Portable fundus camera image: 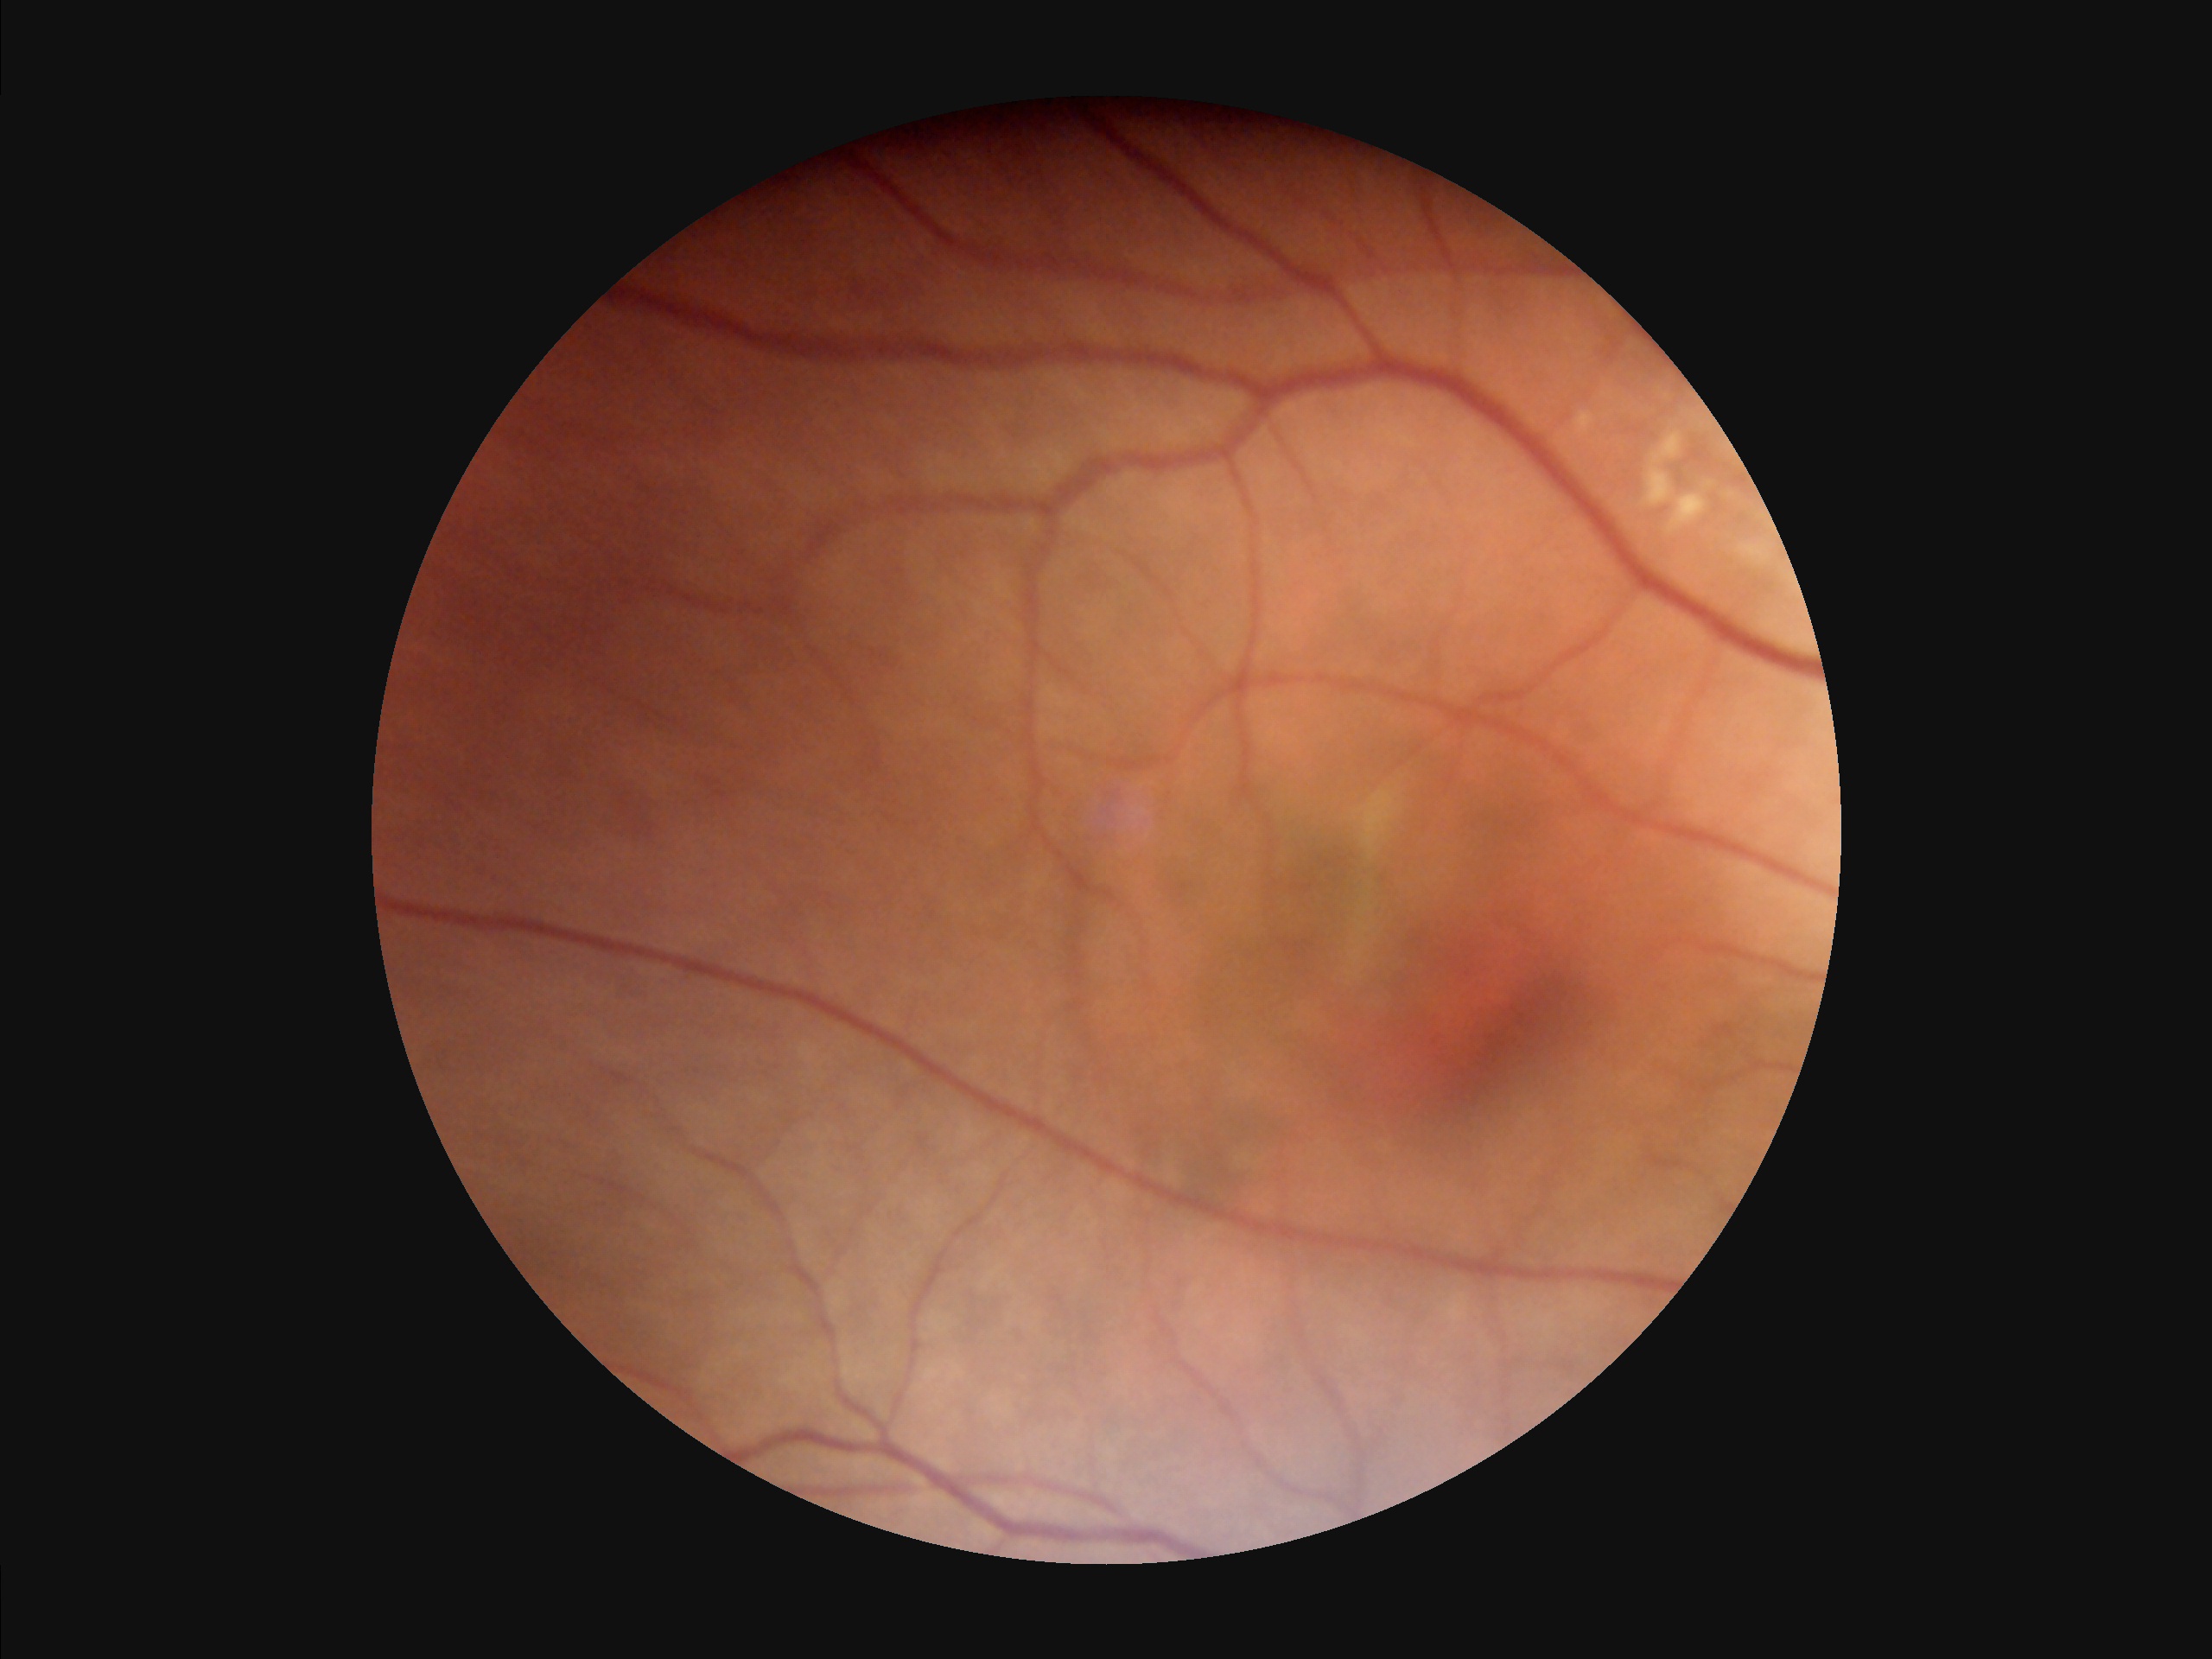

Vessels and details are readily distinguishable. Optic disc, vessels, and background are in focus. No over- or under-exposure.